45° field of view: 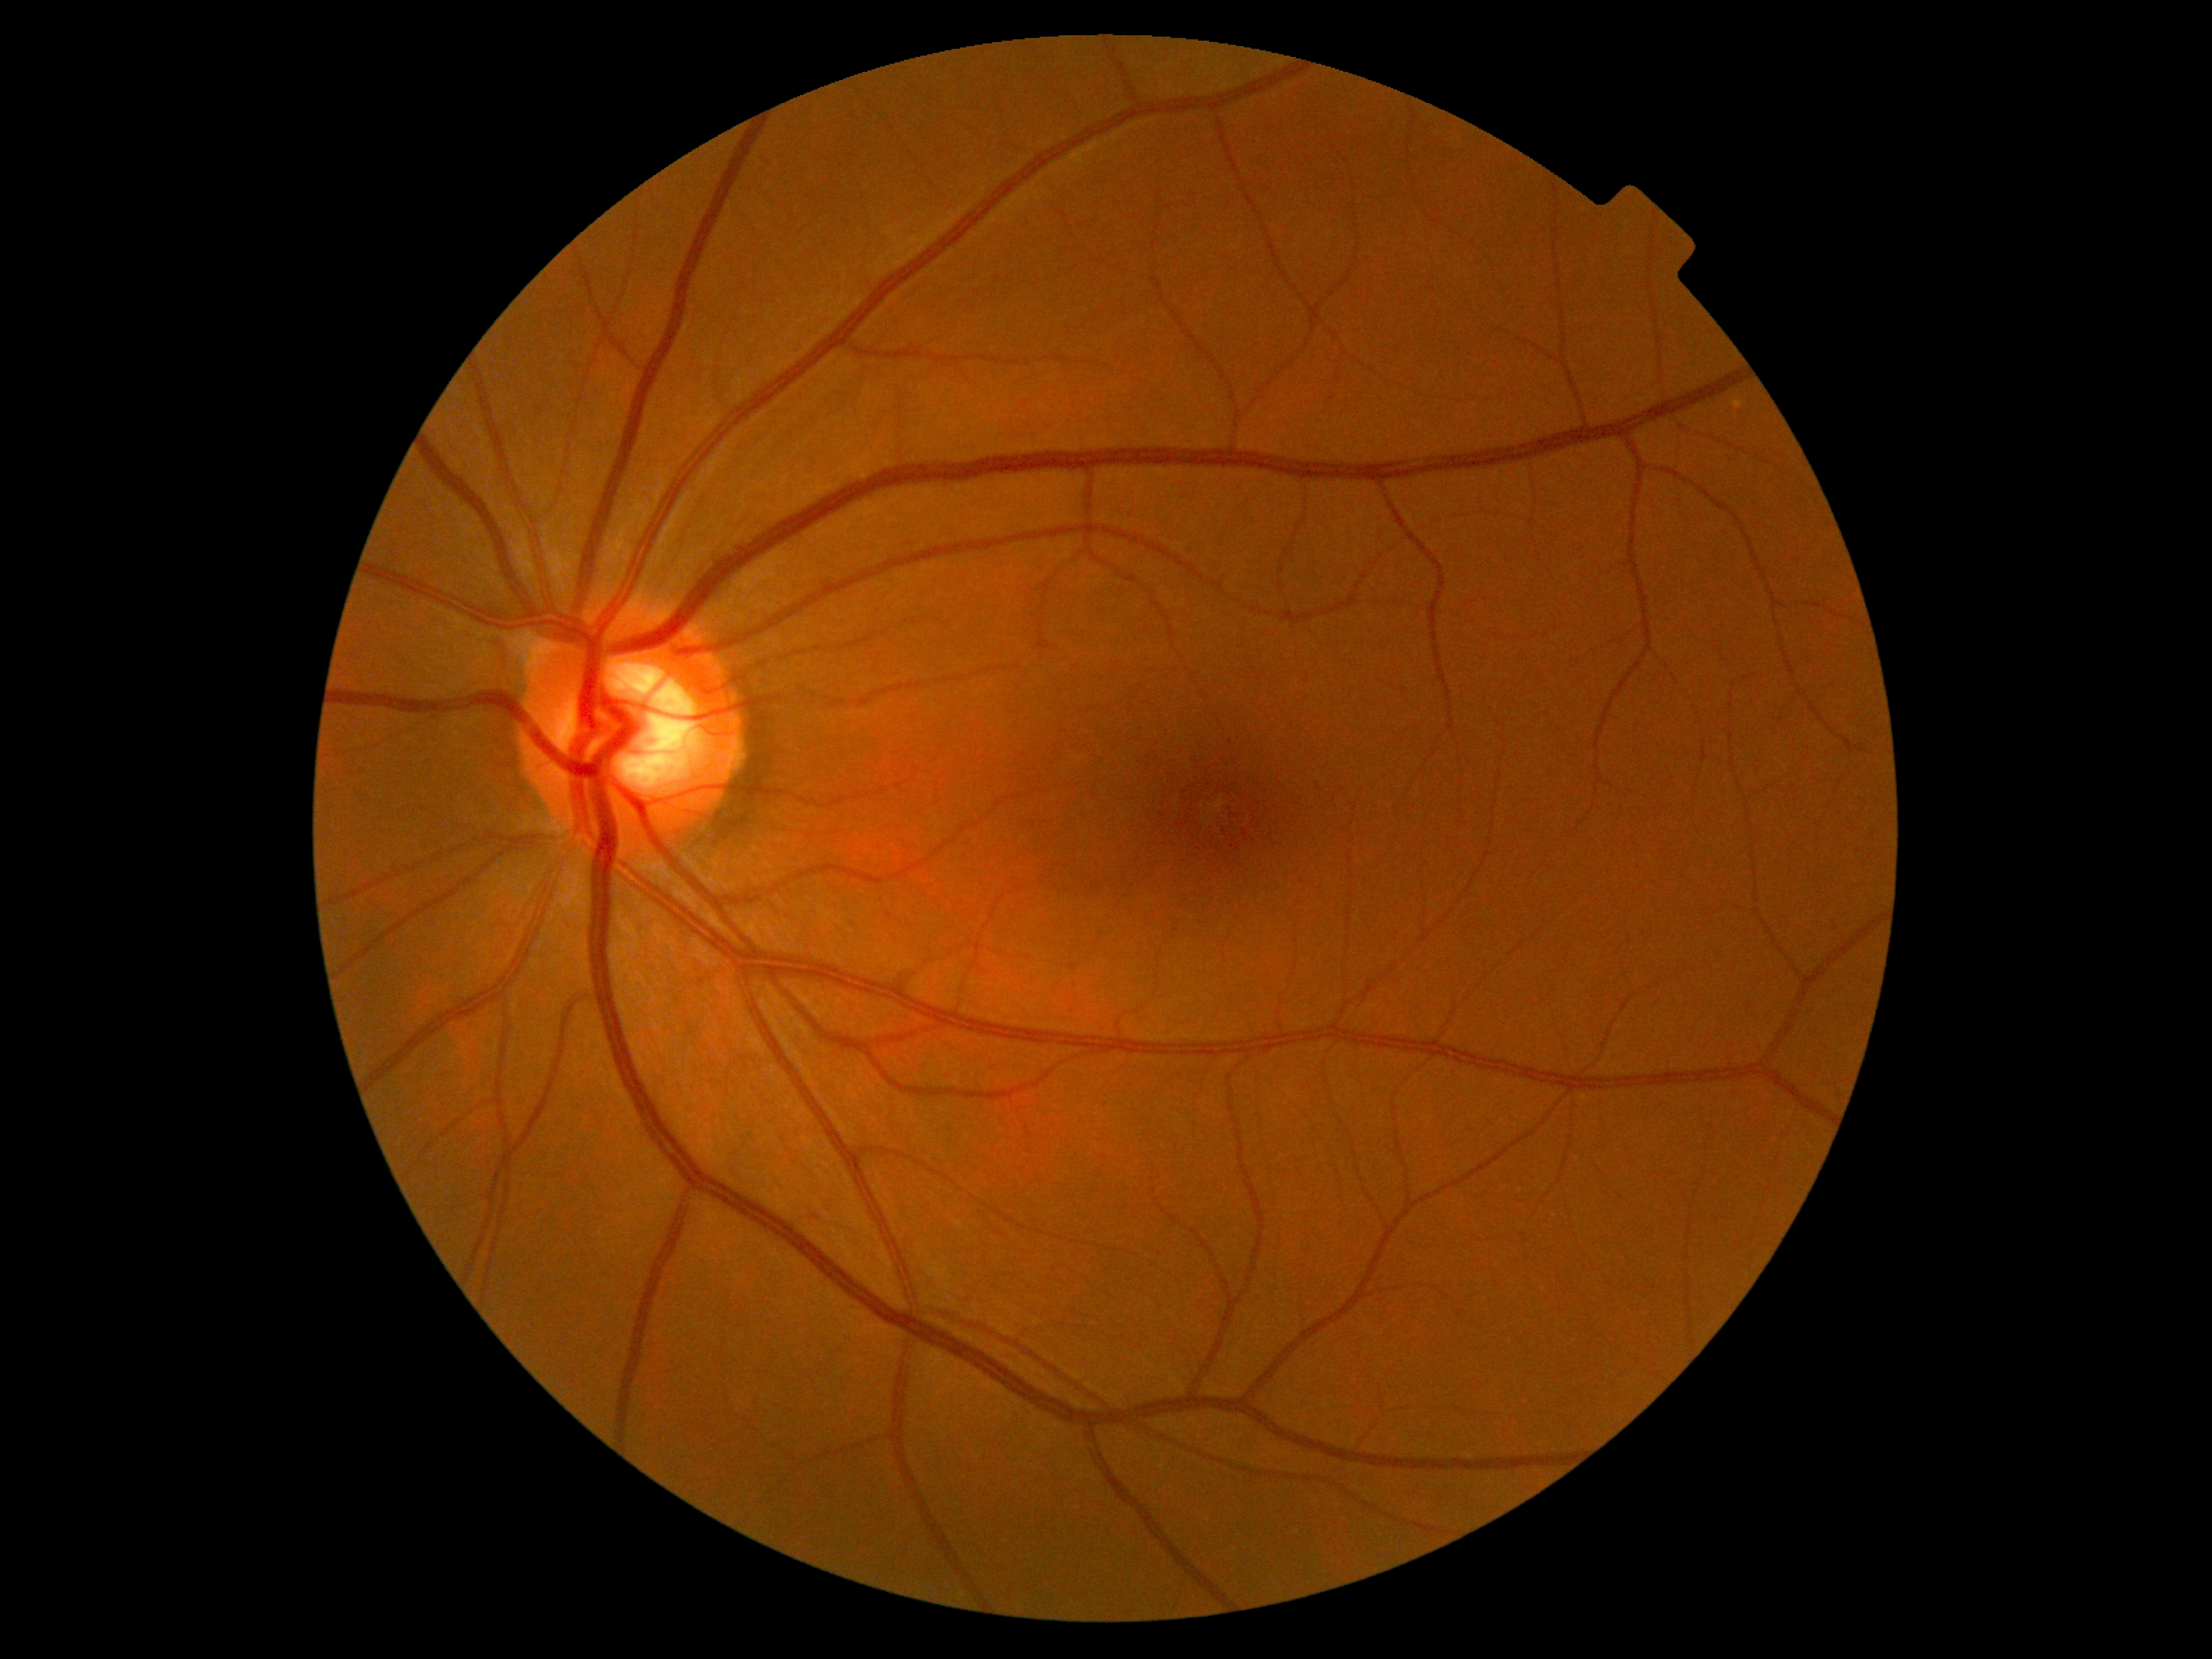
No signs of diabetic retinopathy. DR stage is grade 0 (no apparent retinopathy) — no visible signs of diabetic retinopathy.